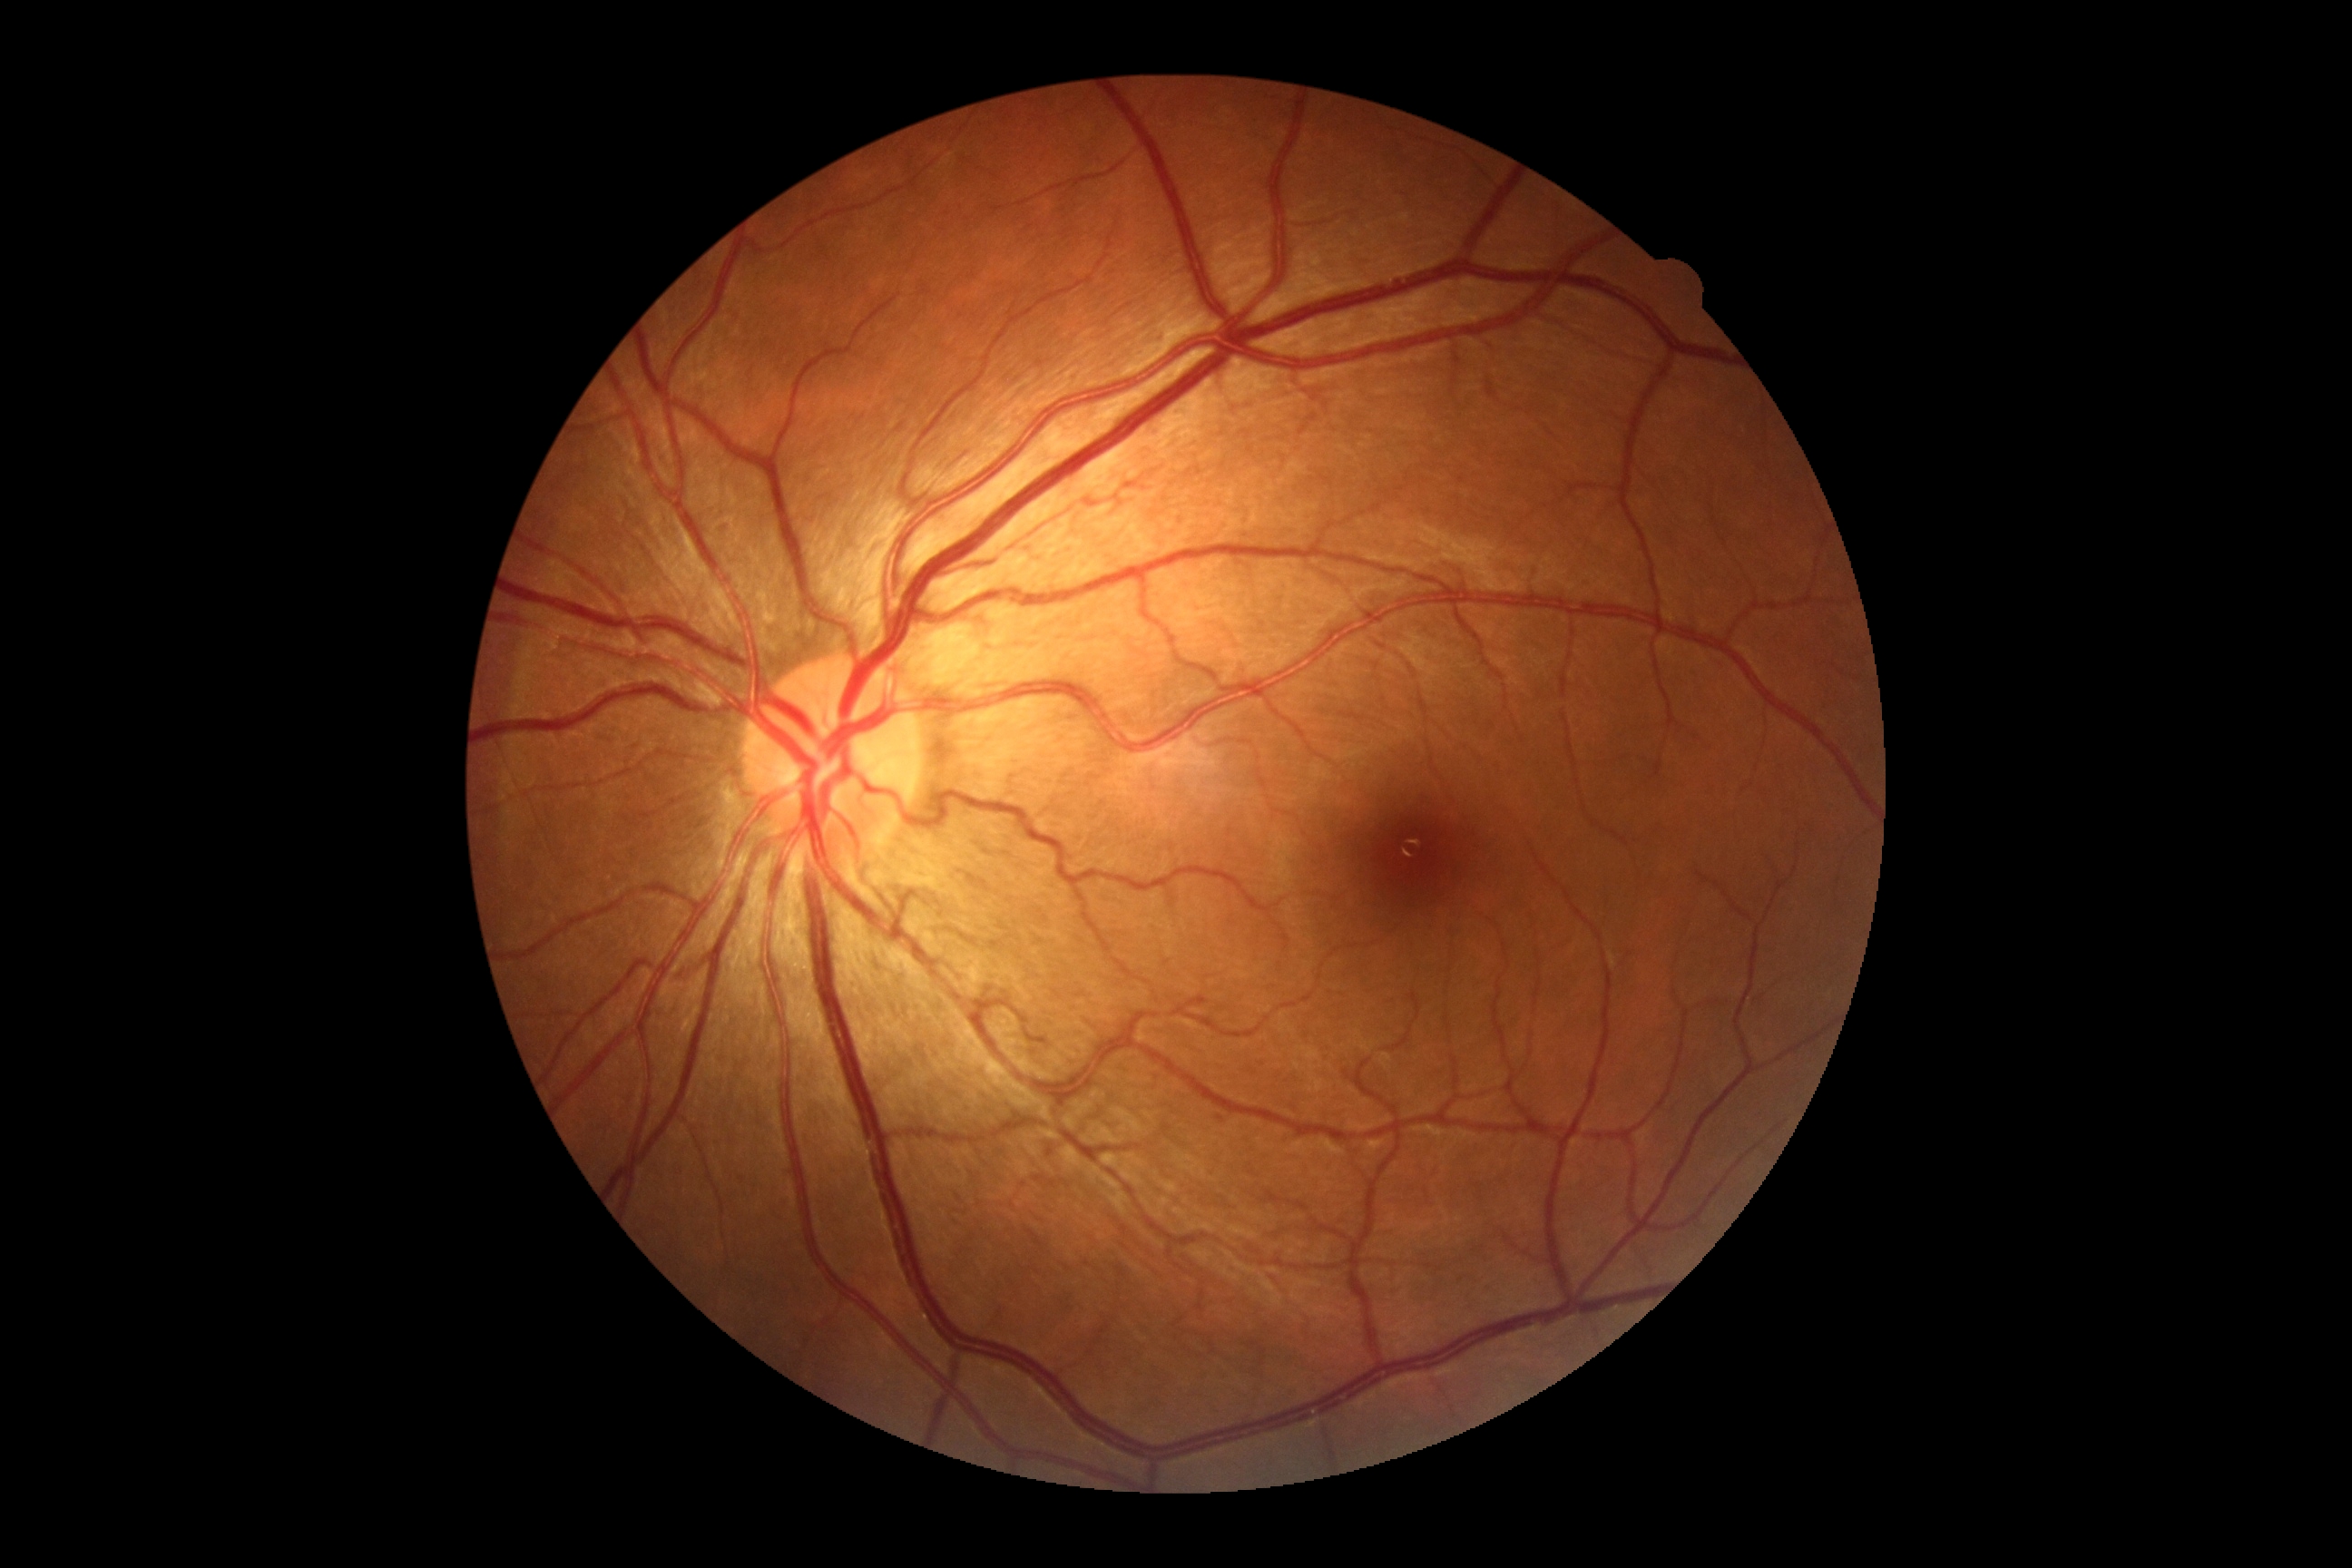
- diabetic retinopathy (DR) — 0